2212 by 1659 pixels
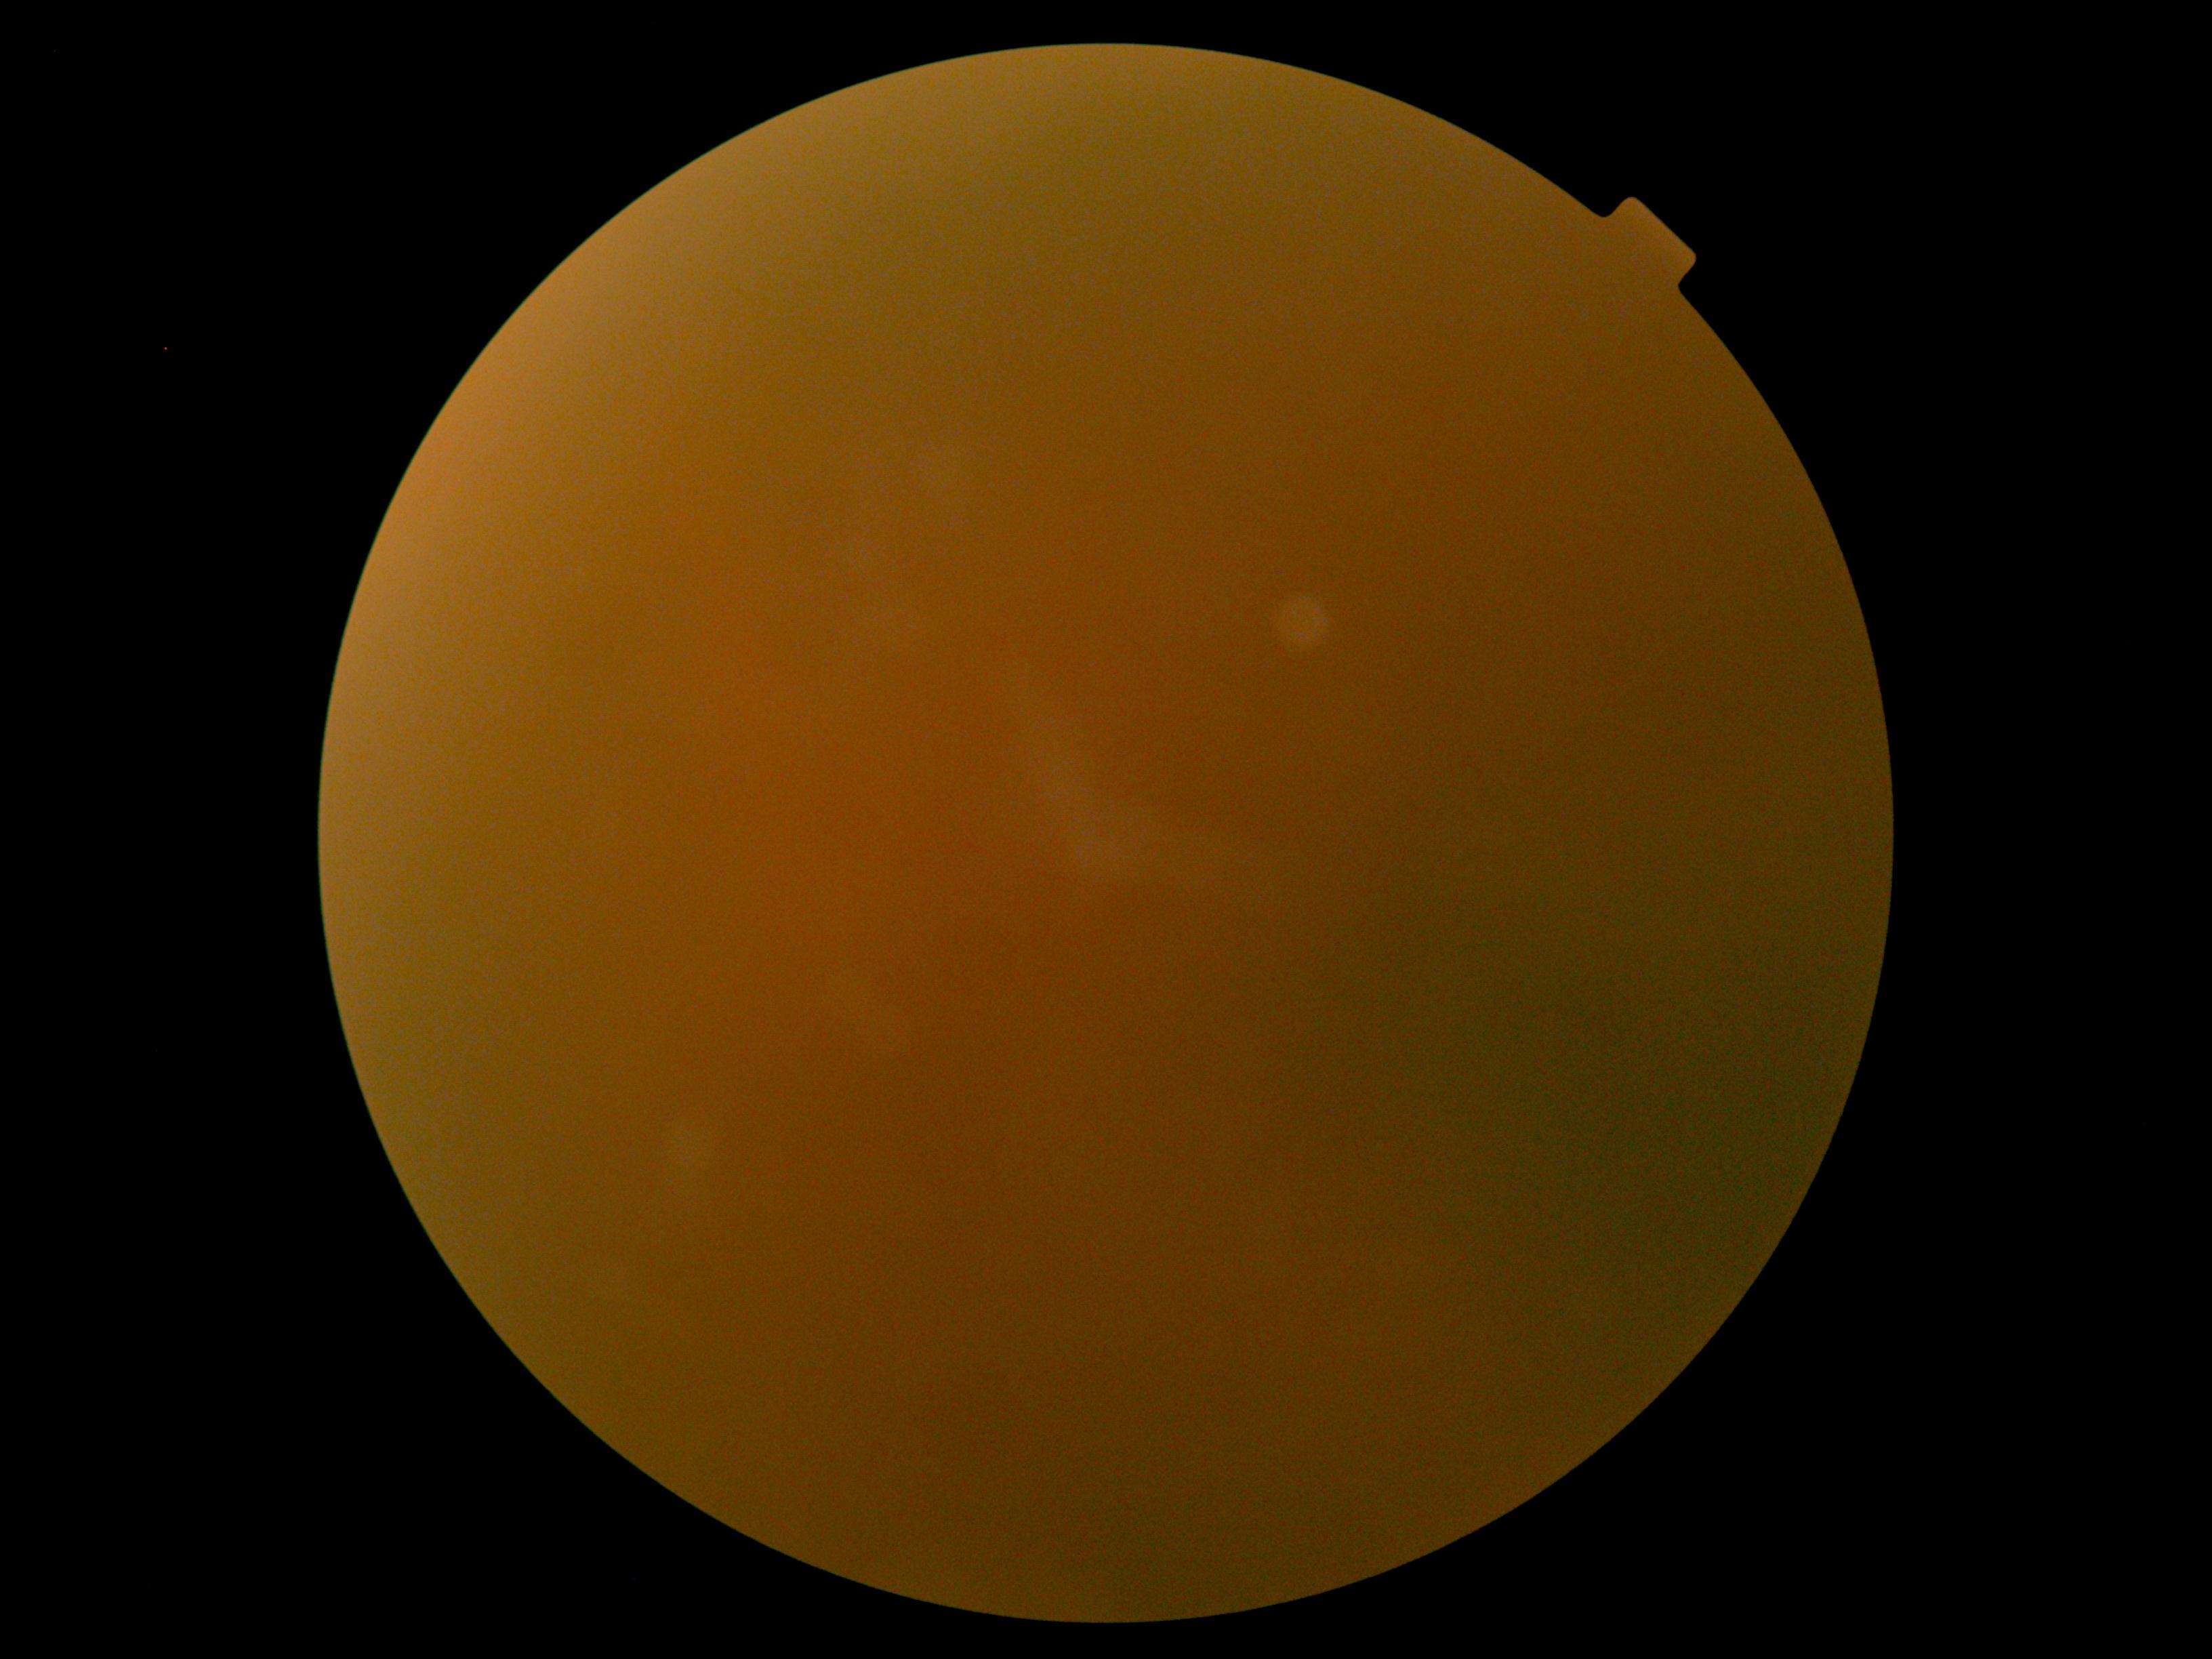

image quality: below grading threshold; diabetic retinopathy (DR): ungradable.